Clarity RetCam 3, 130° FOV; wide-field fundus image from infant ROP screening: 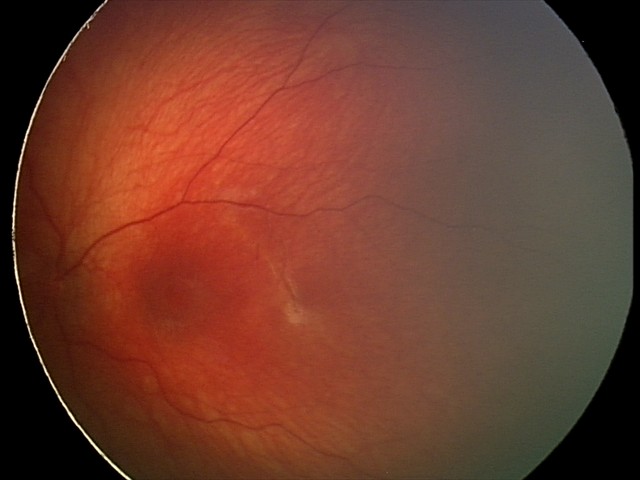
Physiological retinal appearance for postconceptual age.